2212 by 1659 pixels: 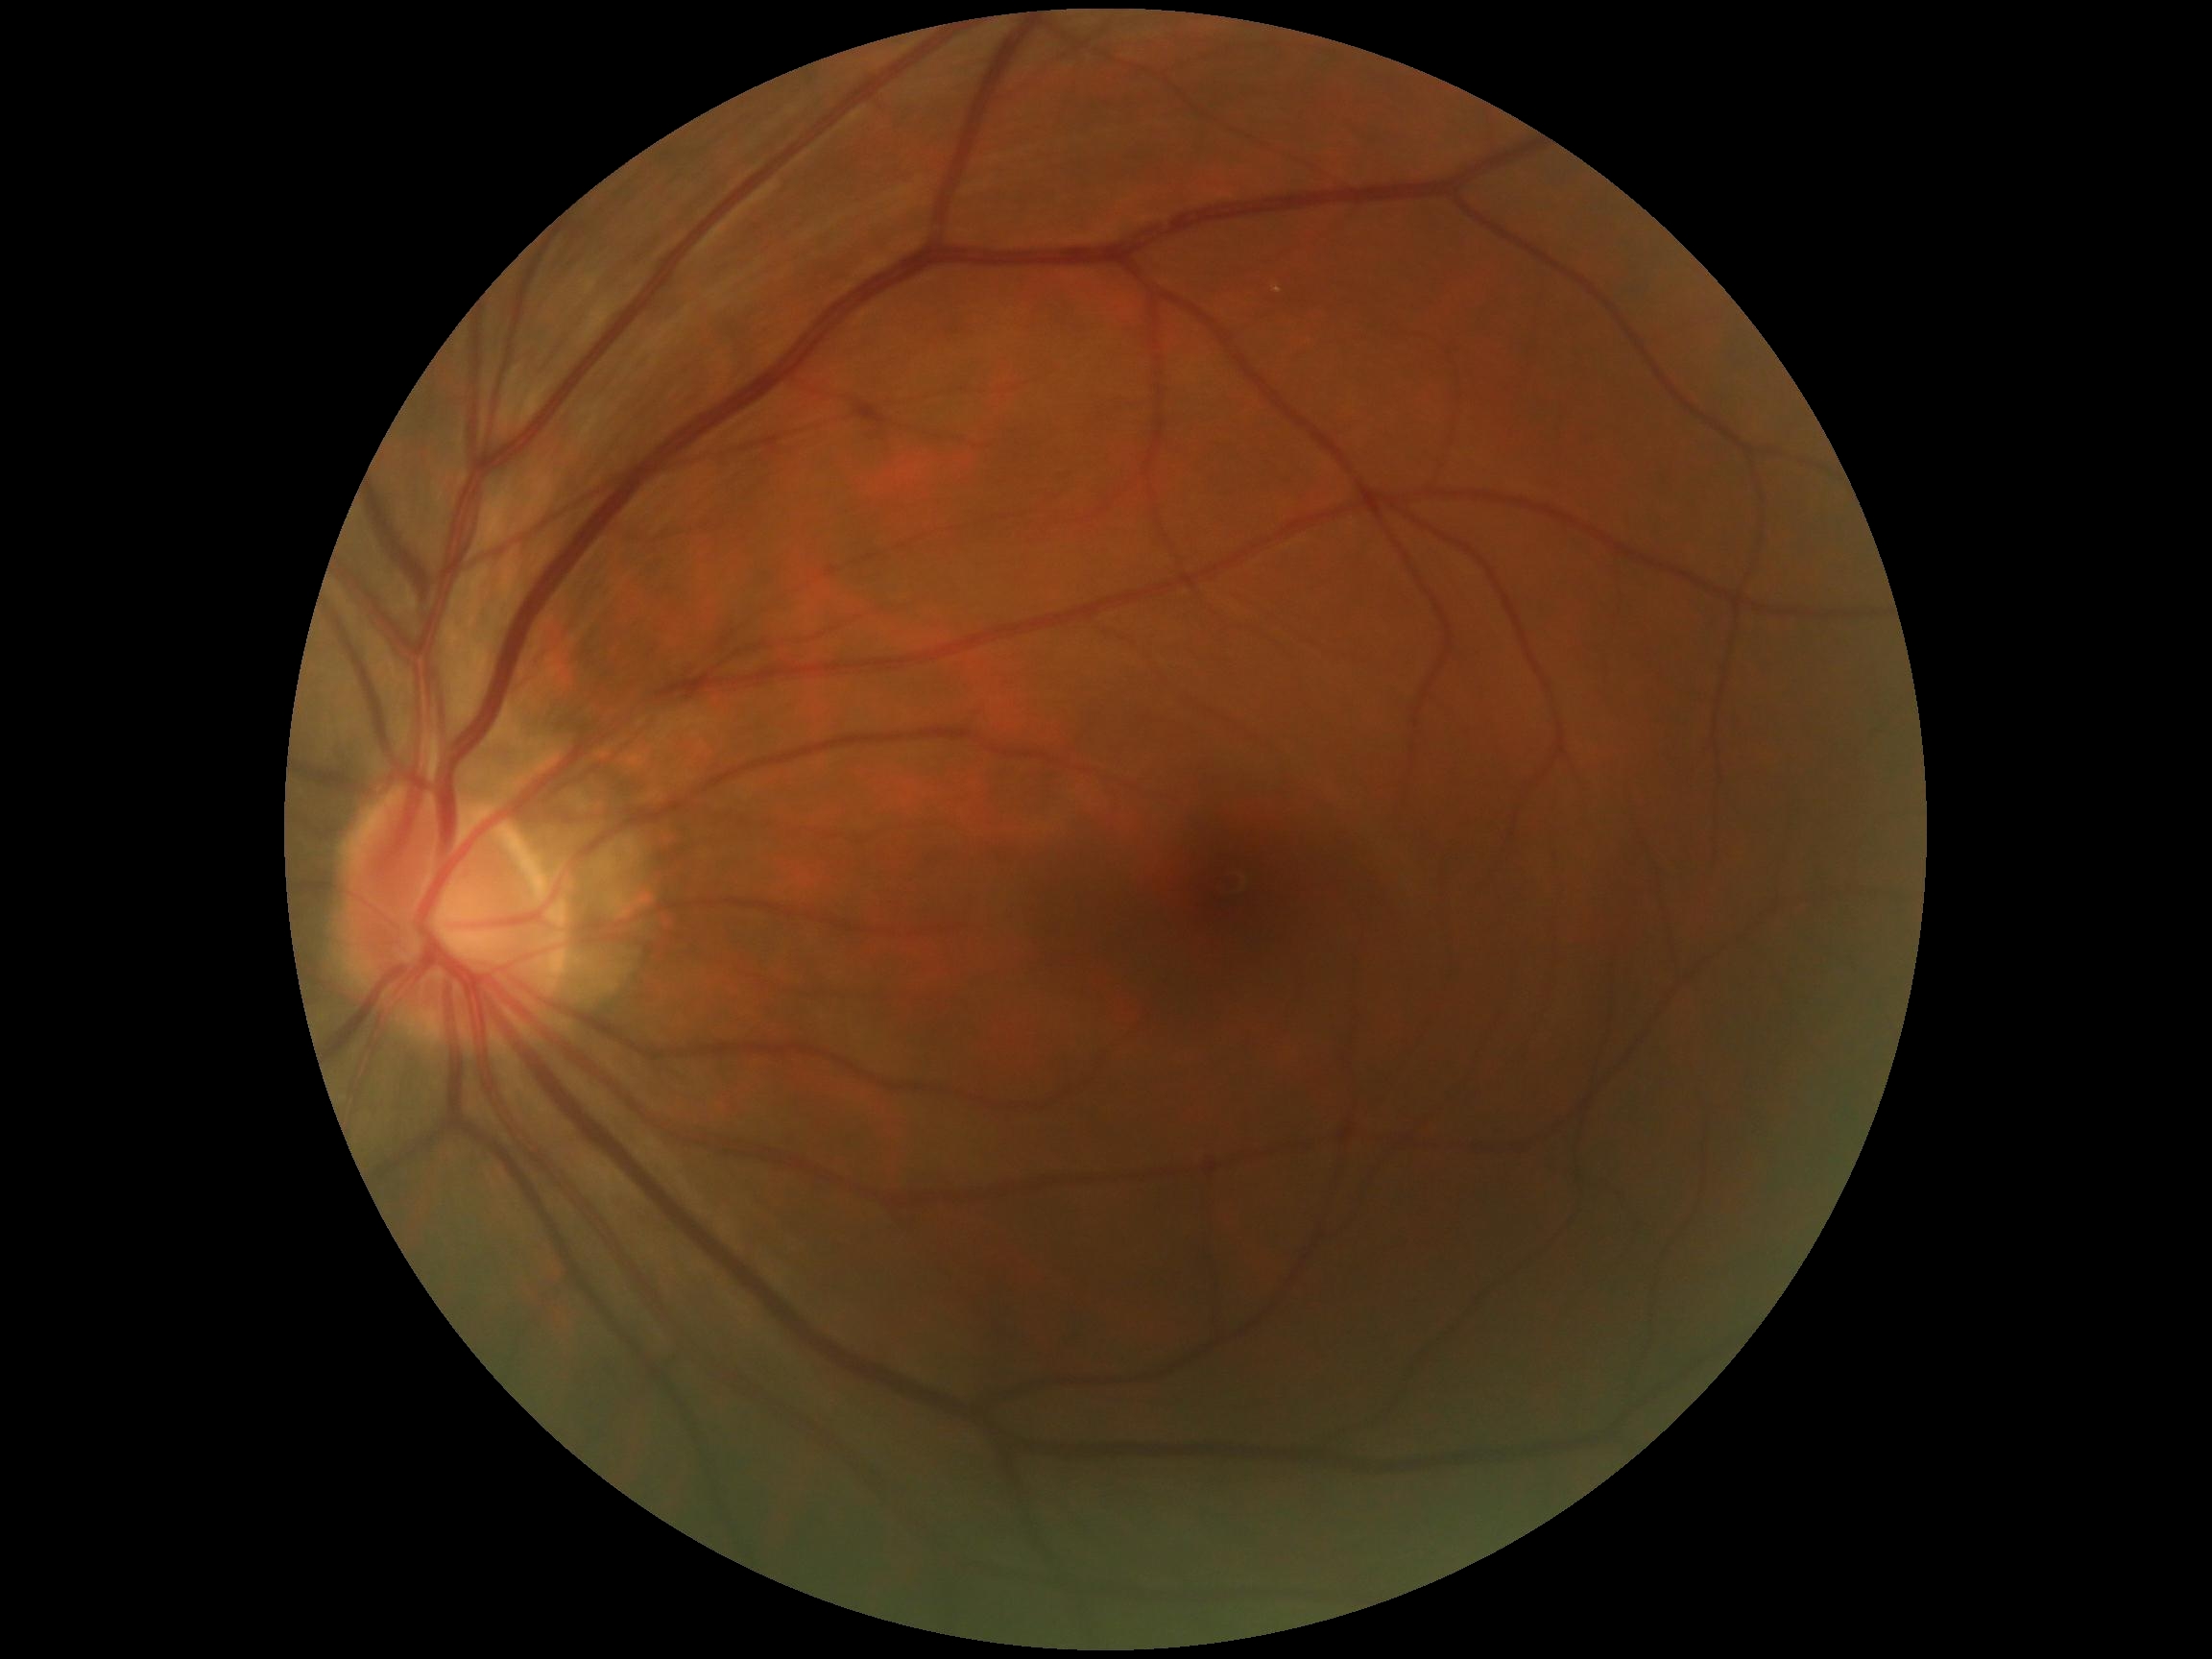
DR grade: 0.